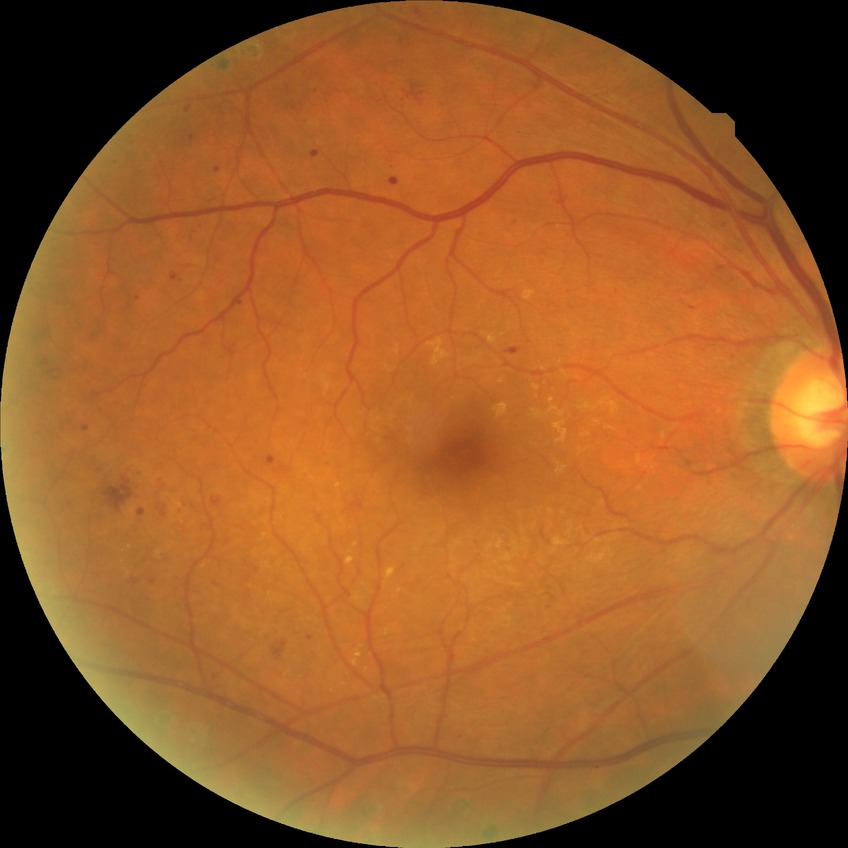 DR is PDR.